Infant wide-field fundus photograph; 1440 x 1080 pixels — 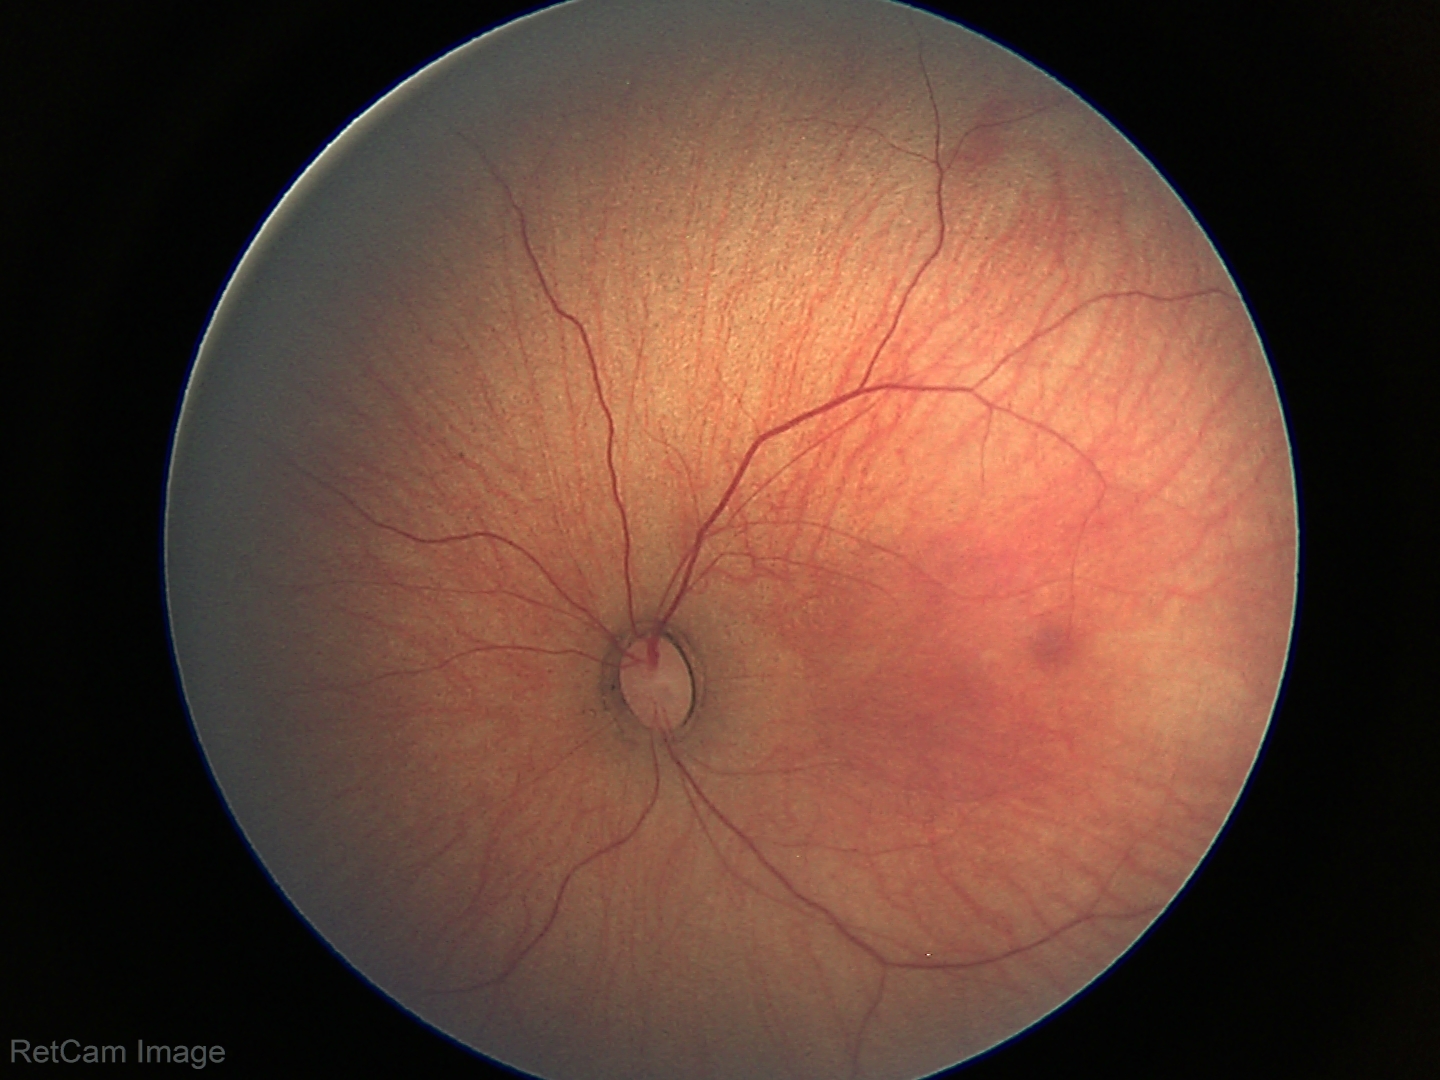 Q: What was the screening finding?
A: normal fundus examination